Diabetic retinopathy graded by the modified Davis classification
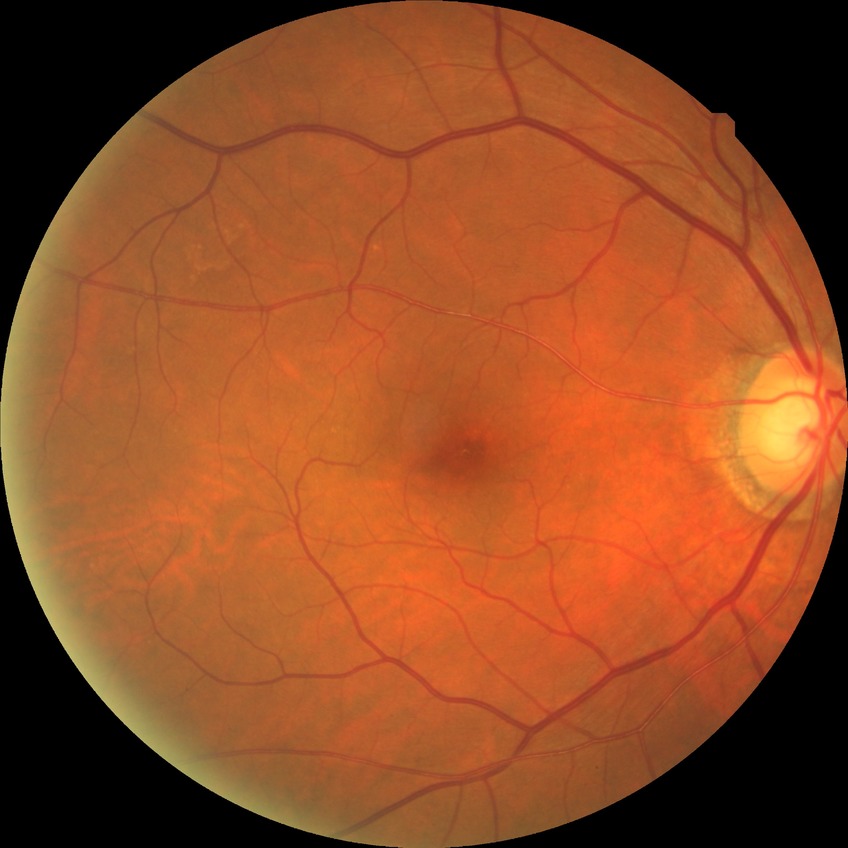
Diabetic retinopathy (DR): no diabetic retinopathy (NDR).